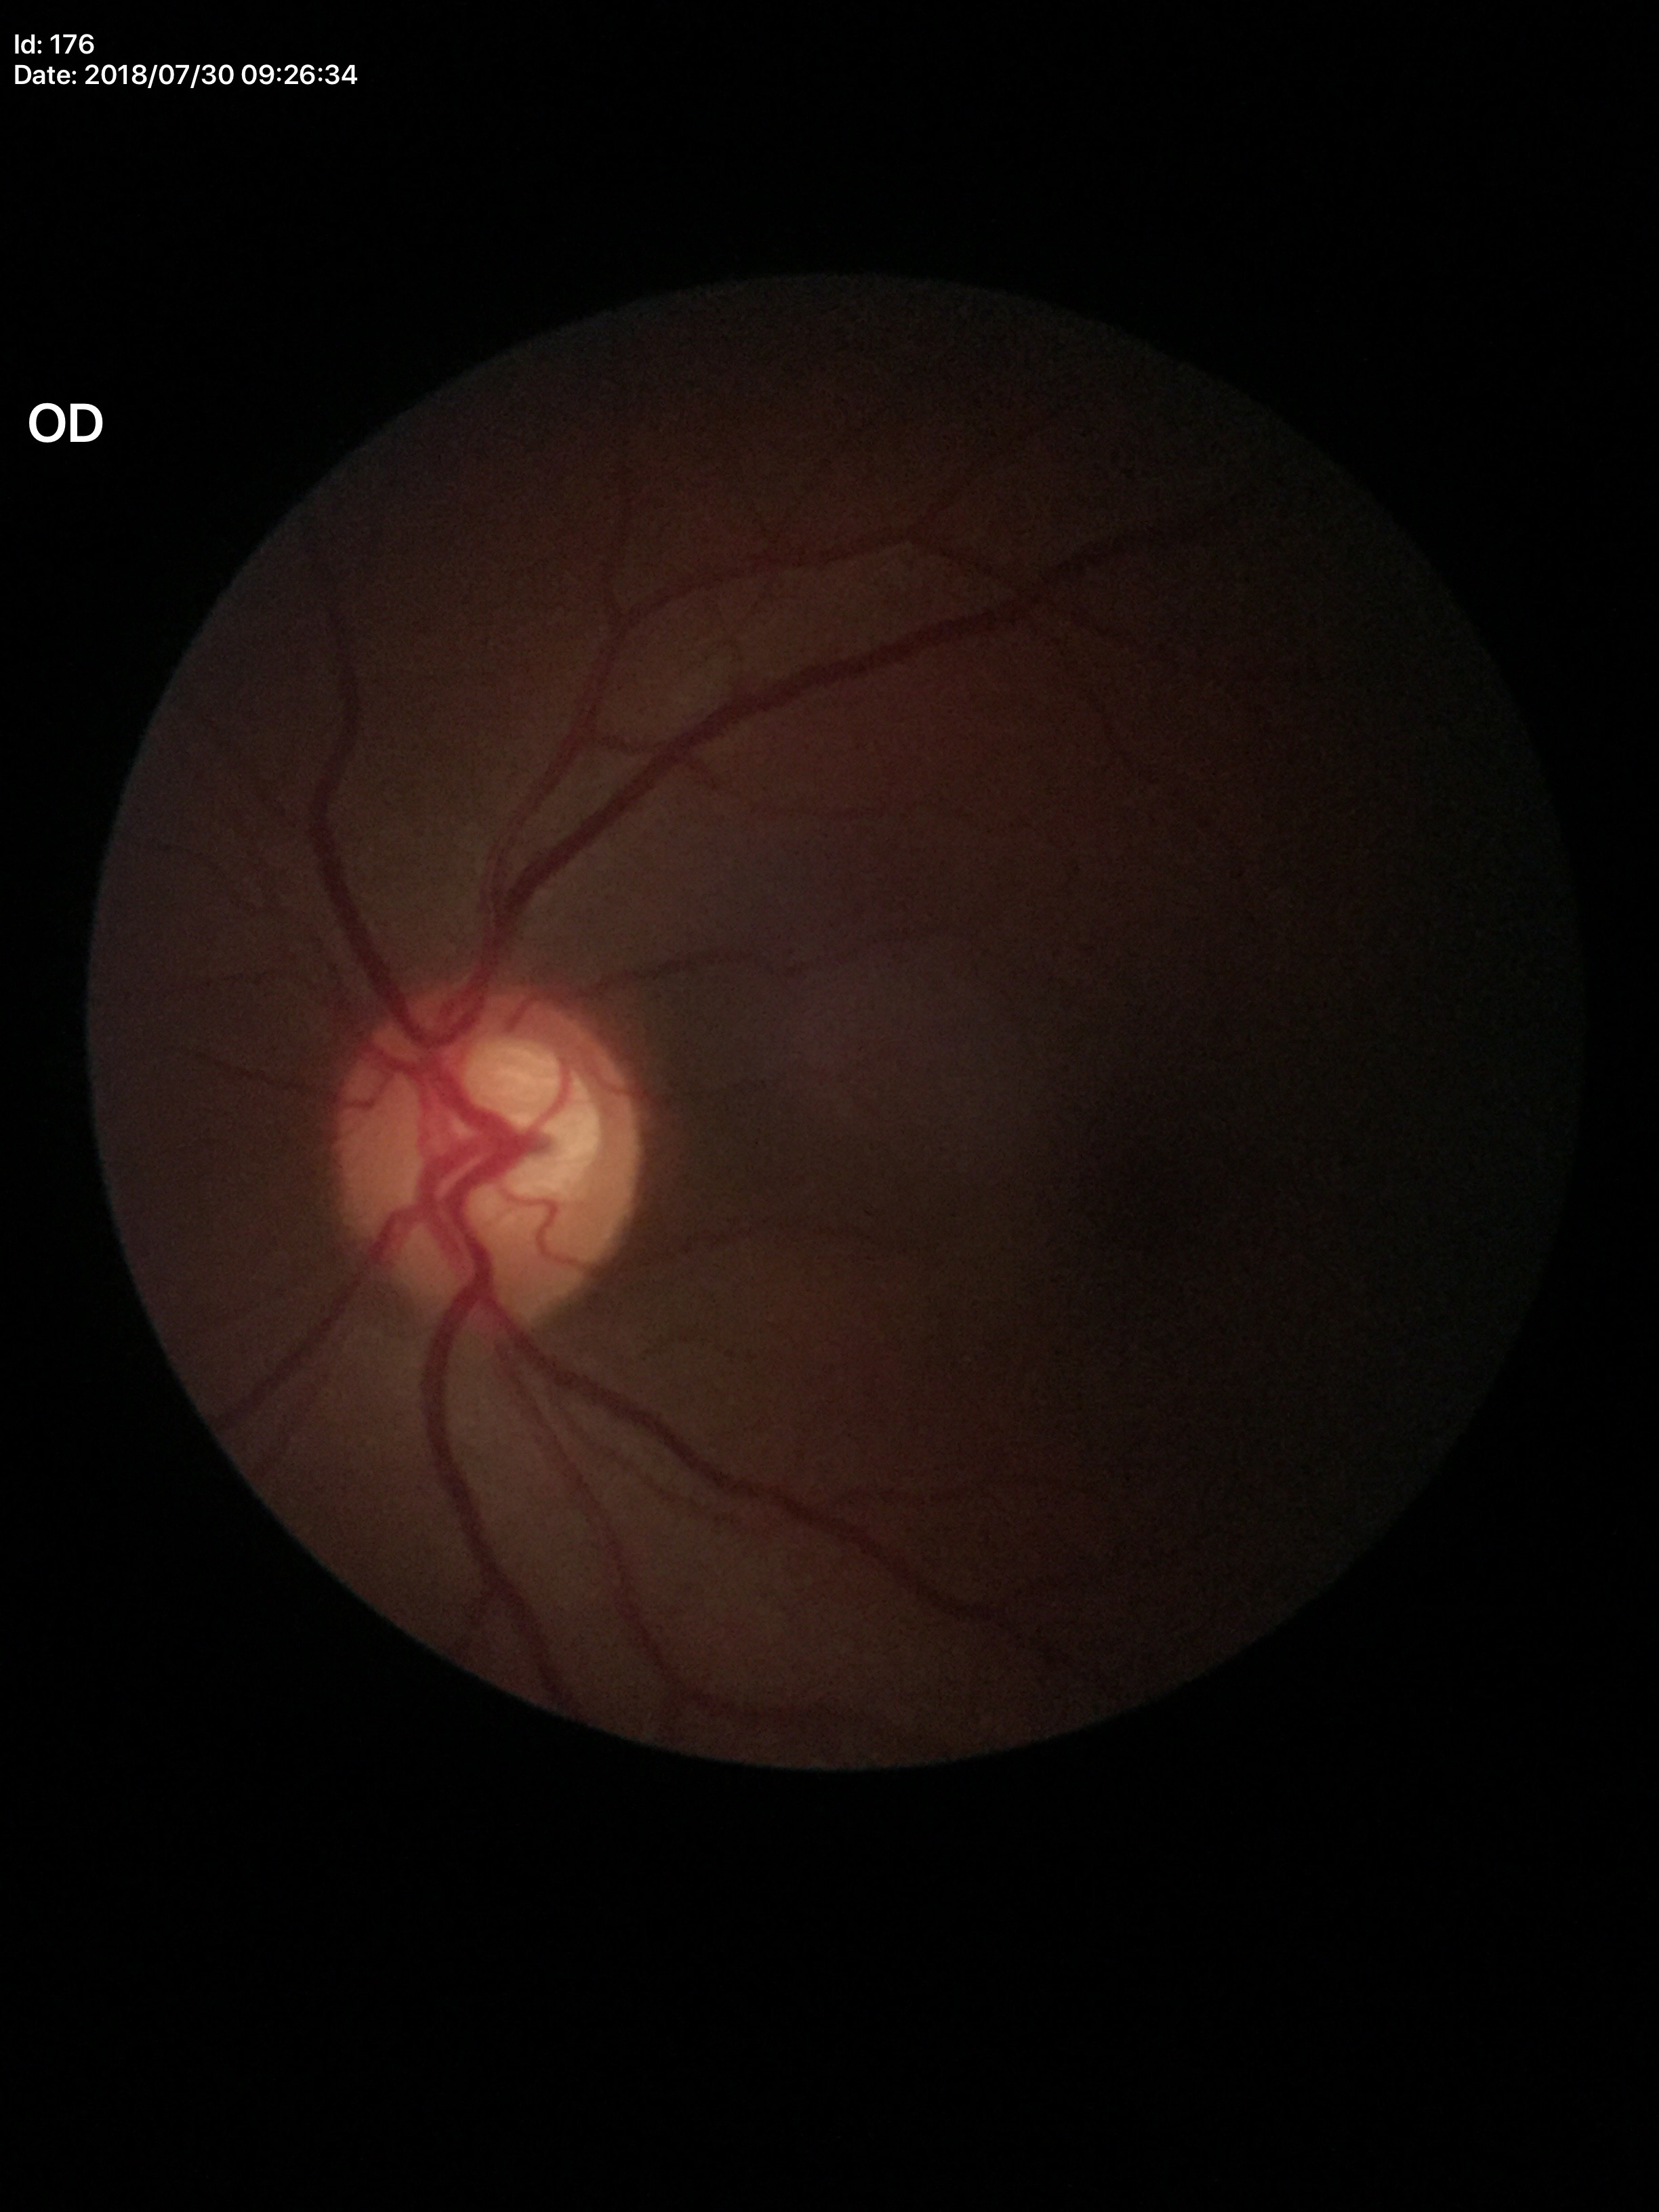

Glaucoma decision: suspicious findings (three of five ophthalmologists flagged glaucoma suspect).
Vertical CDR (VCDR): 0.62.